Image size 1240x1240. Wide-field fundus photograph of an infant.
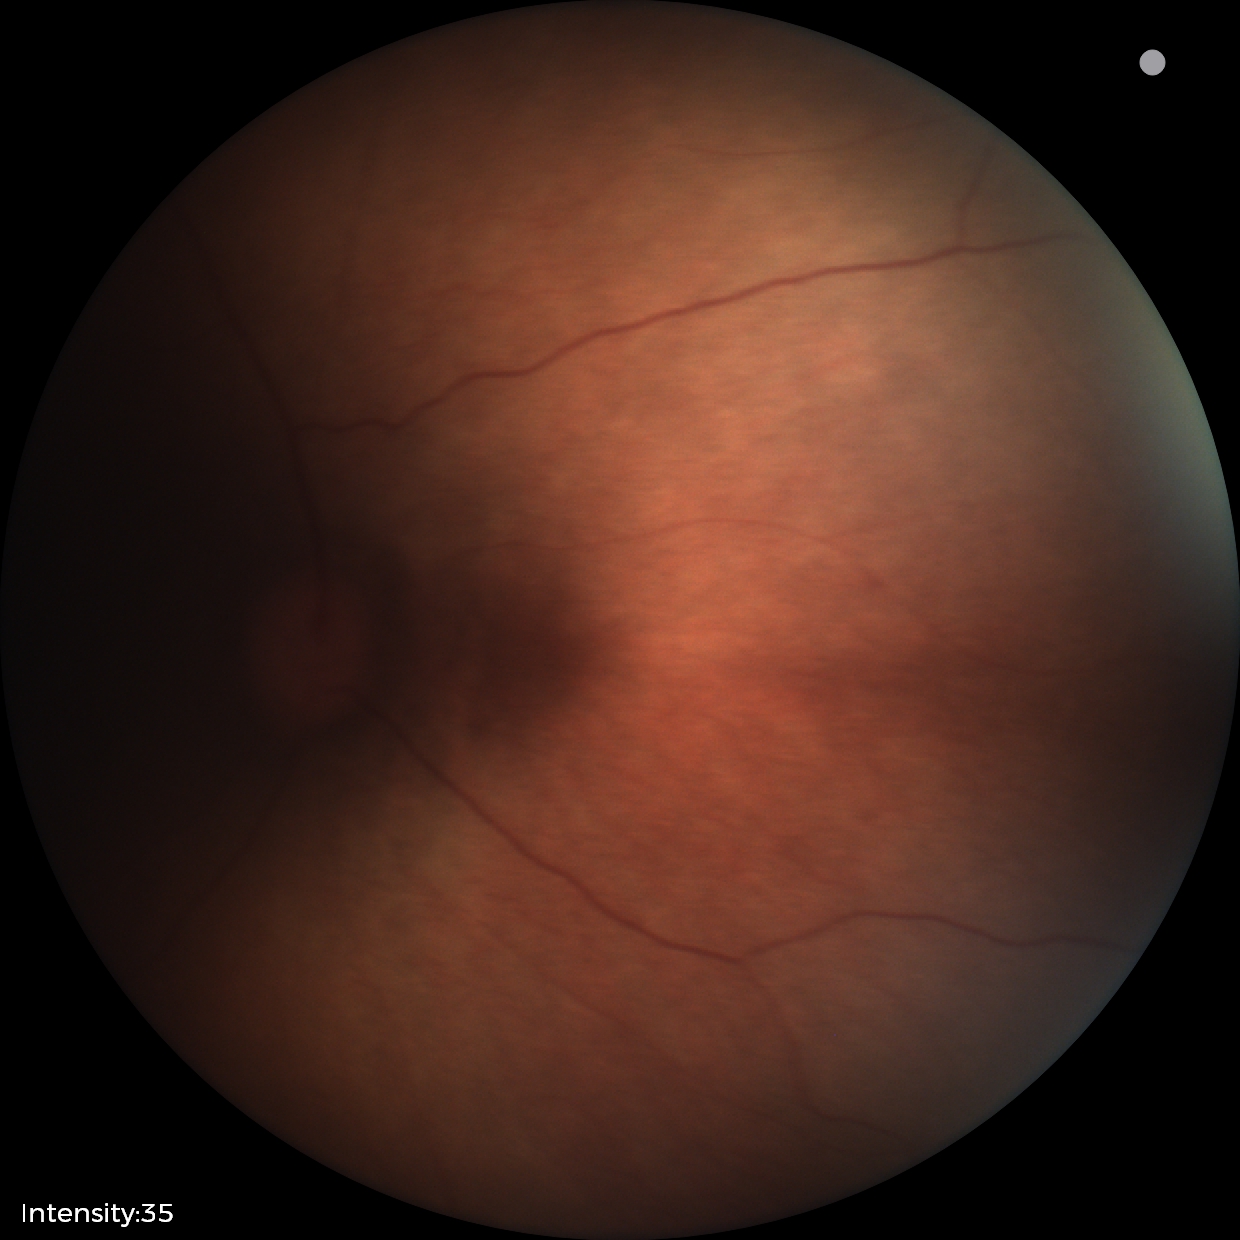
Examination with physiological retinal findings.